Color fundus image:
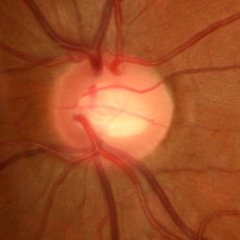
There is evidence of early glaucomatous changes.